DR severity per modified Davis staging, CFP, nonmydriatic fundus photograph
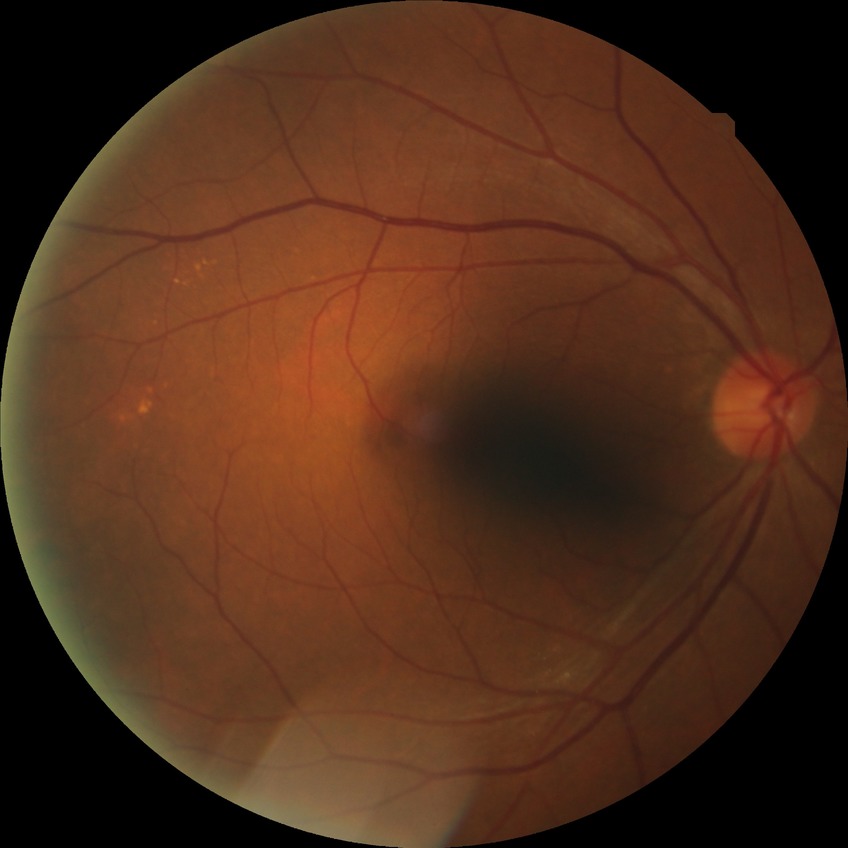

Diabetic retinopathy (DR) is no diabetic retinopathy (NDR).